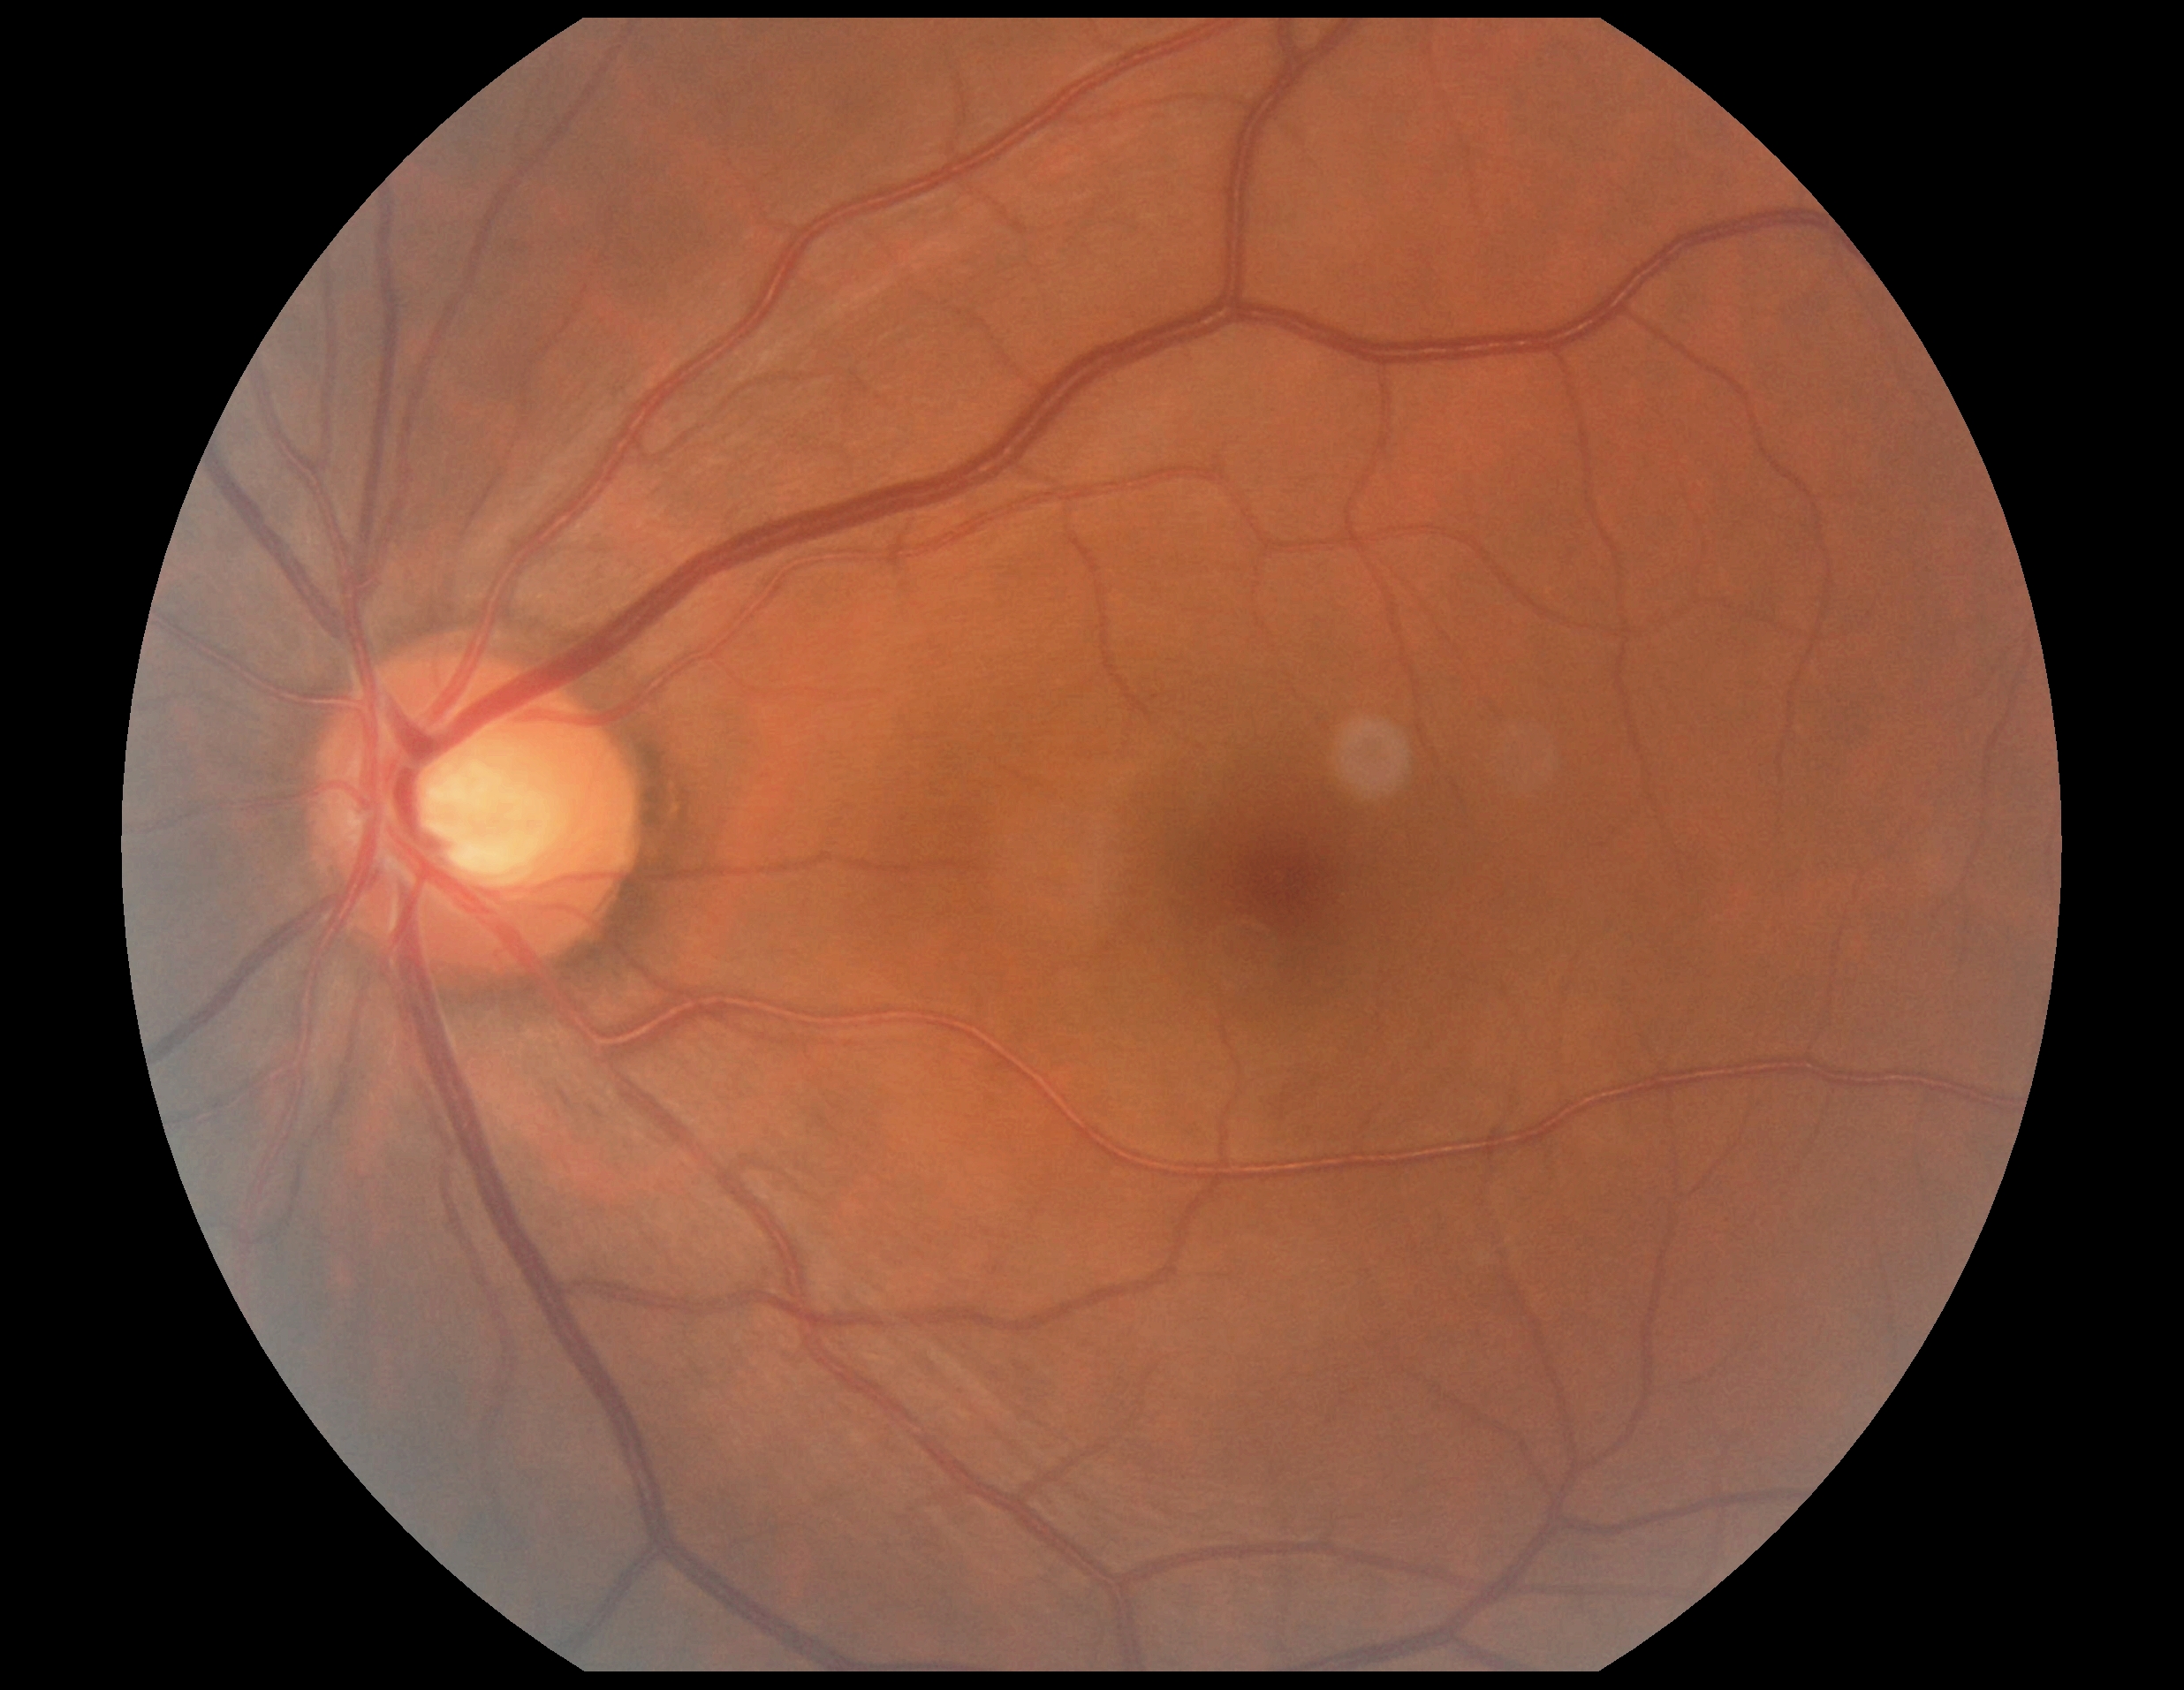 {"dr_grade": "no apparent retinopathy (0)", "dr_impression": "negative for DR"}